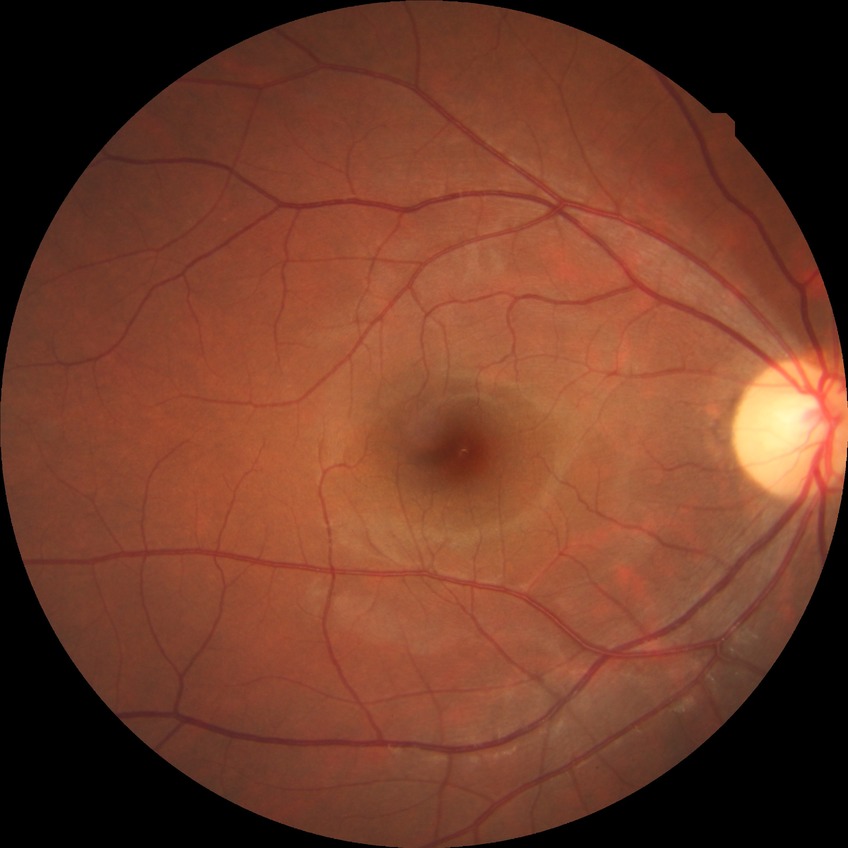
Diabetic retinopathy (DR) is no diabetic retinopathy (NDR).